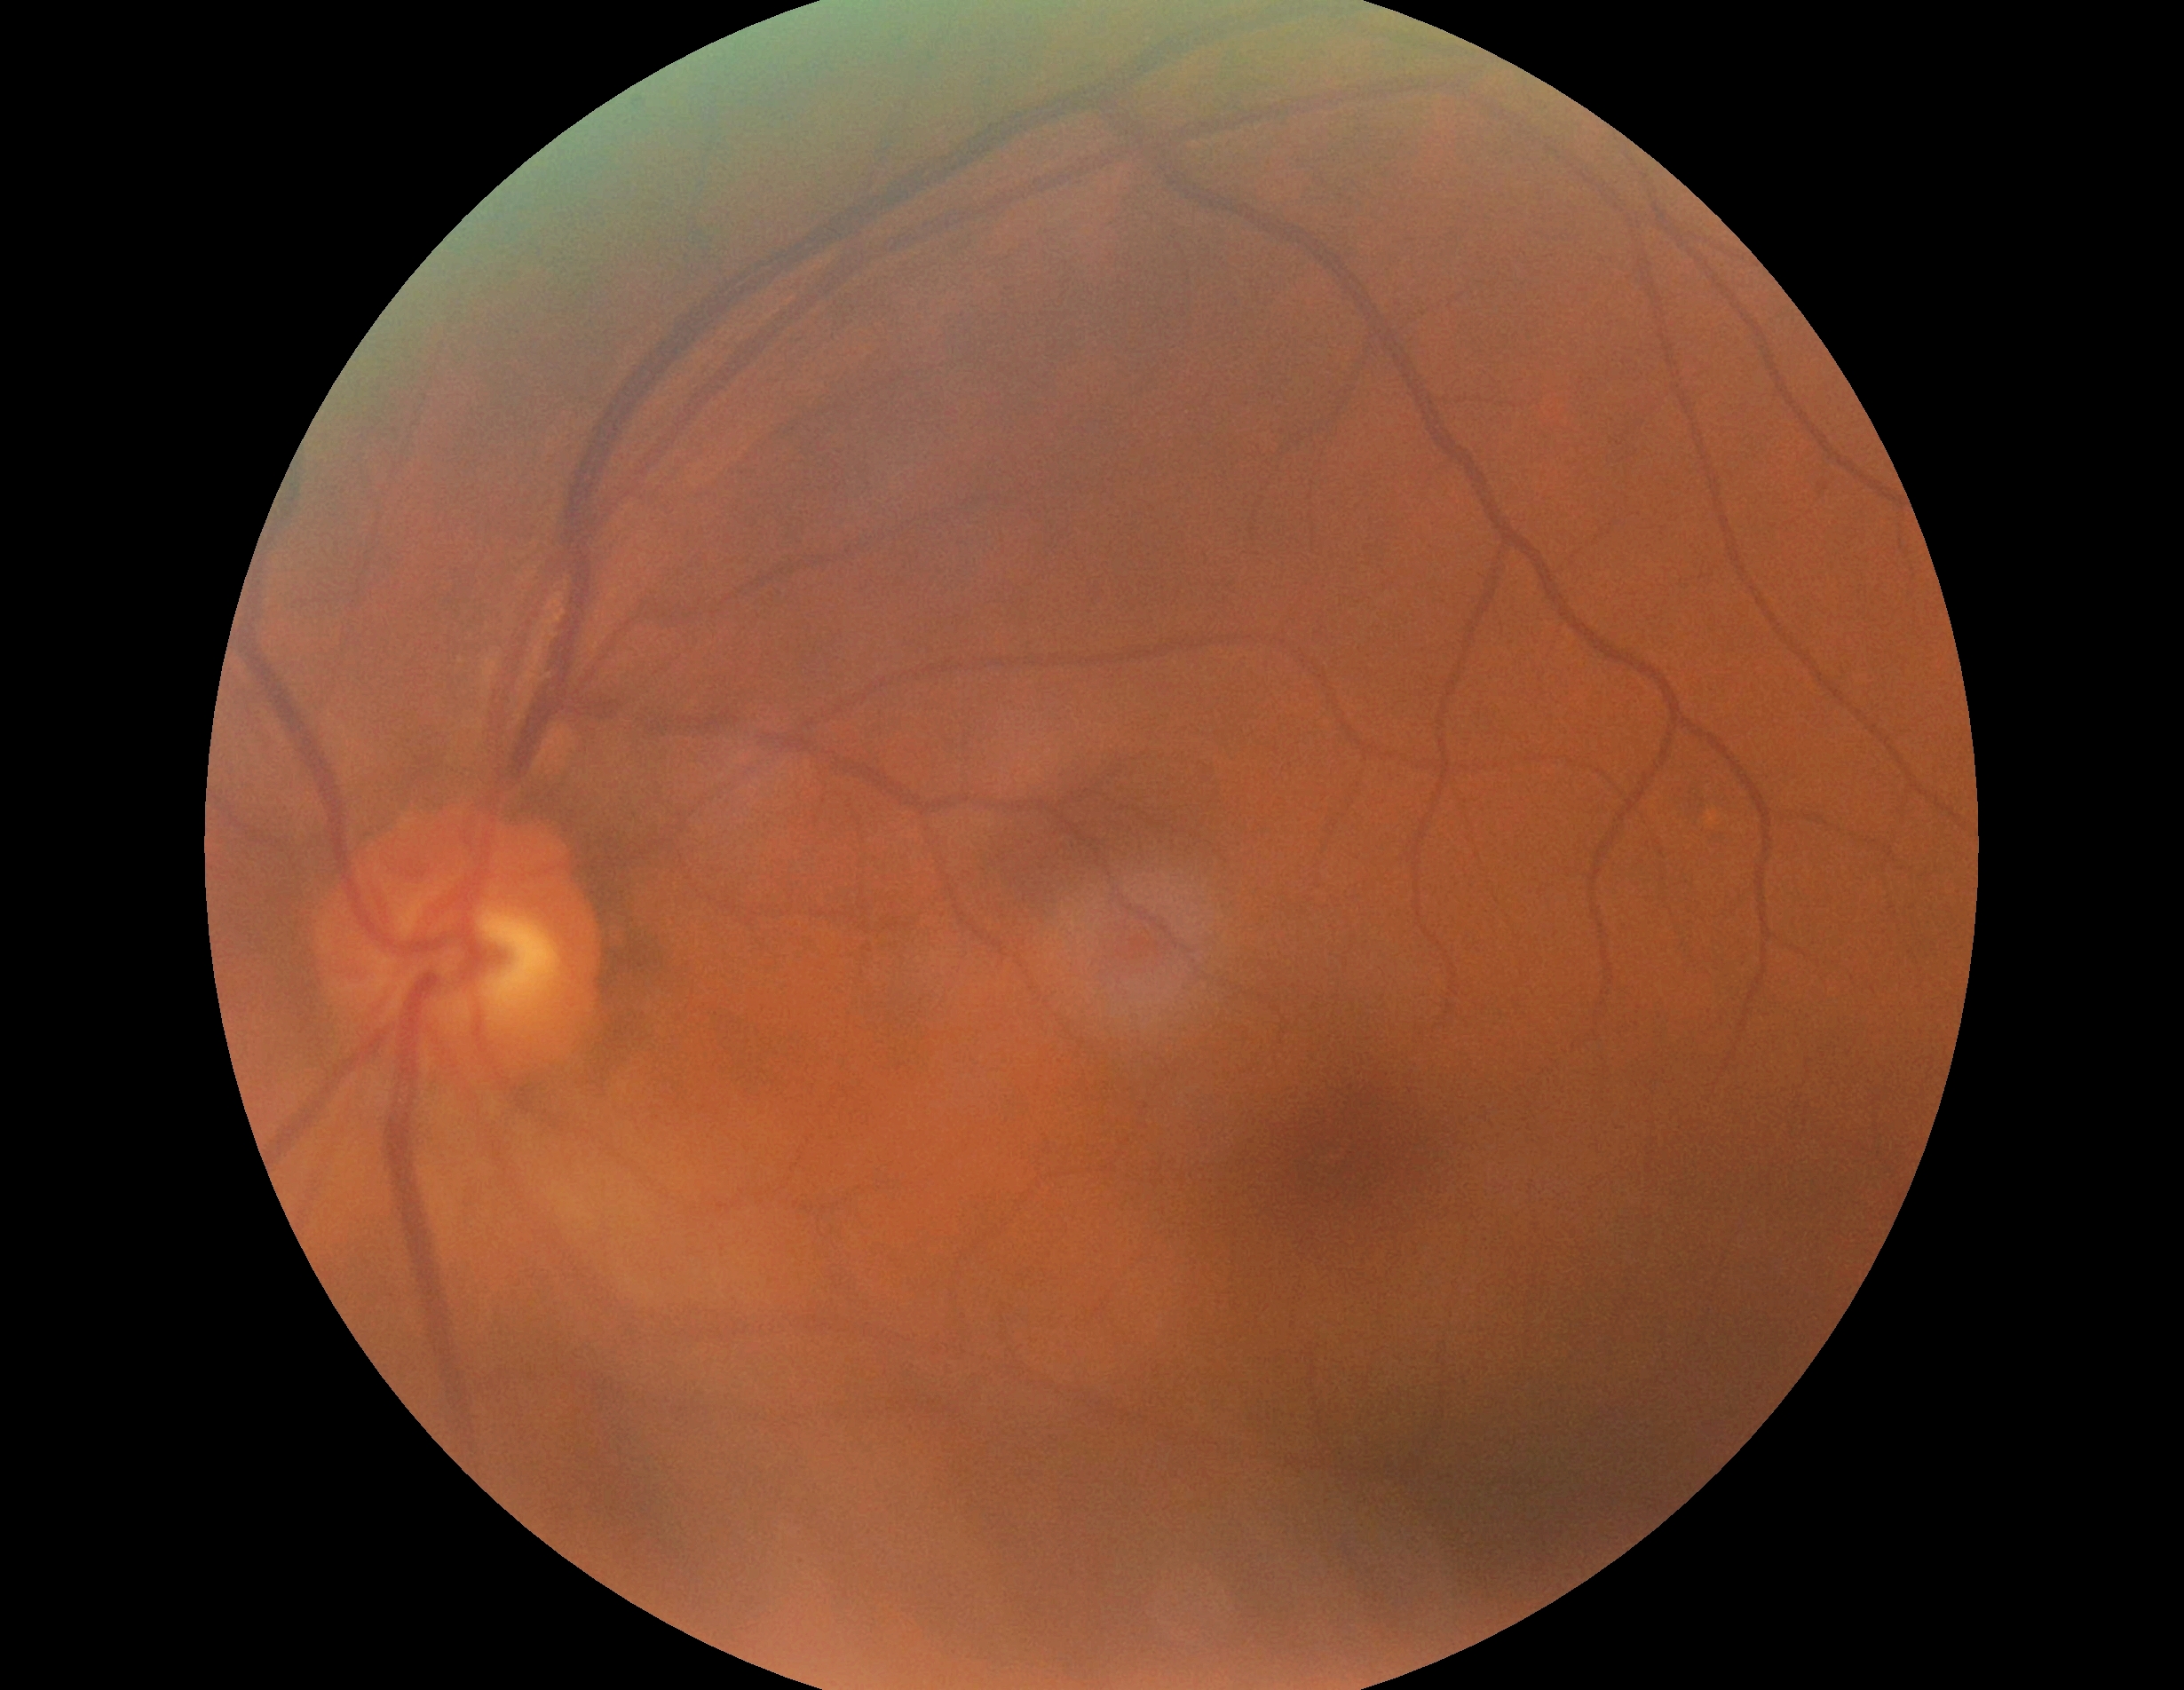 Diabetic retinopathy (DR): grade 0 (no apparent retinopathy).